50° FOV · color fundus photograph.
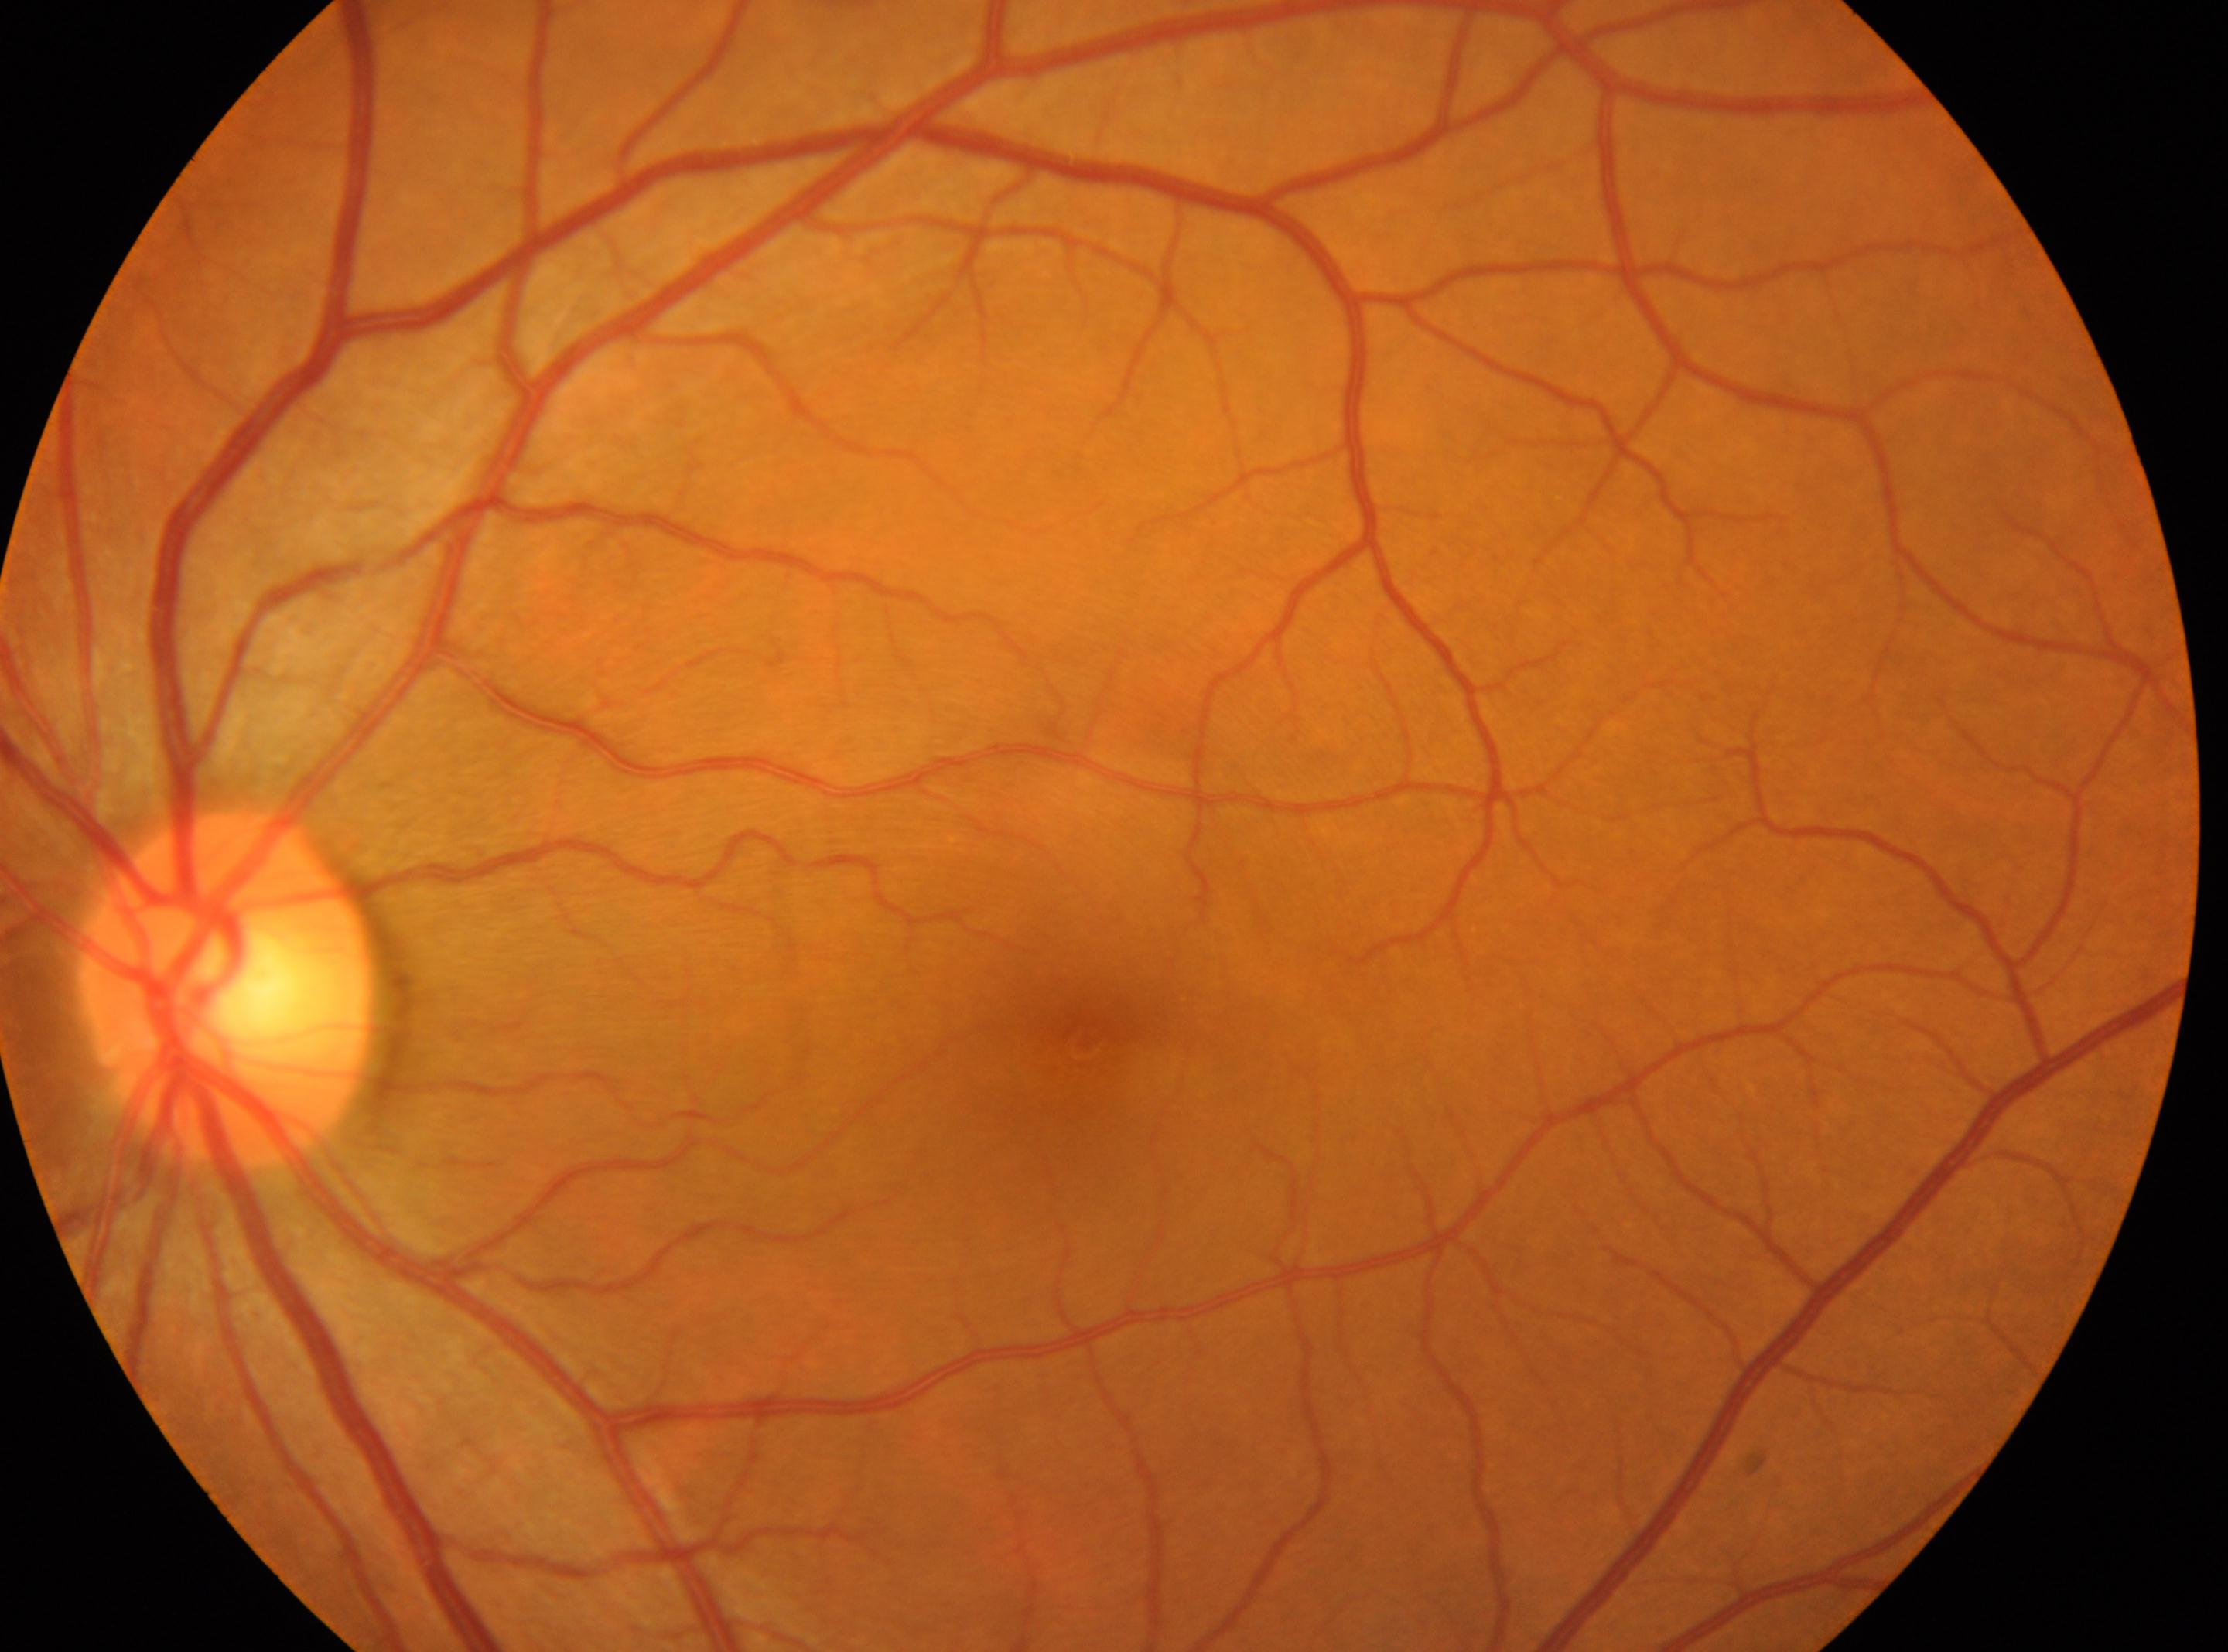
Annotations:
– macular center · [1083, 1043]
– diabetic retinopathy (DR) · no apparent diabetic retinopathy (grade 0)
– laterality · the left eye
– optic disc · [227, 987]